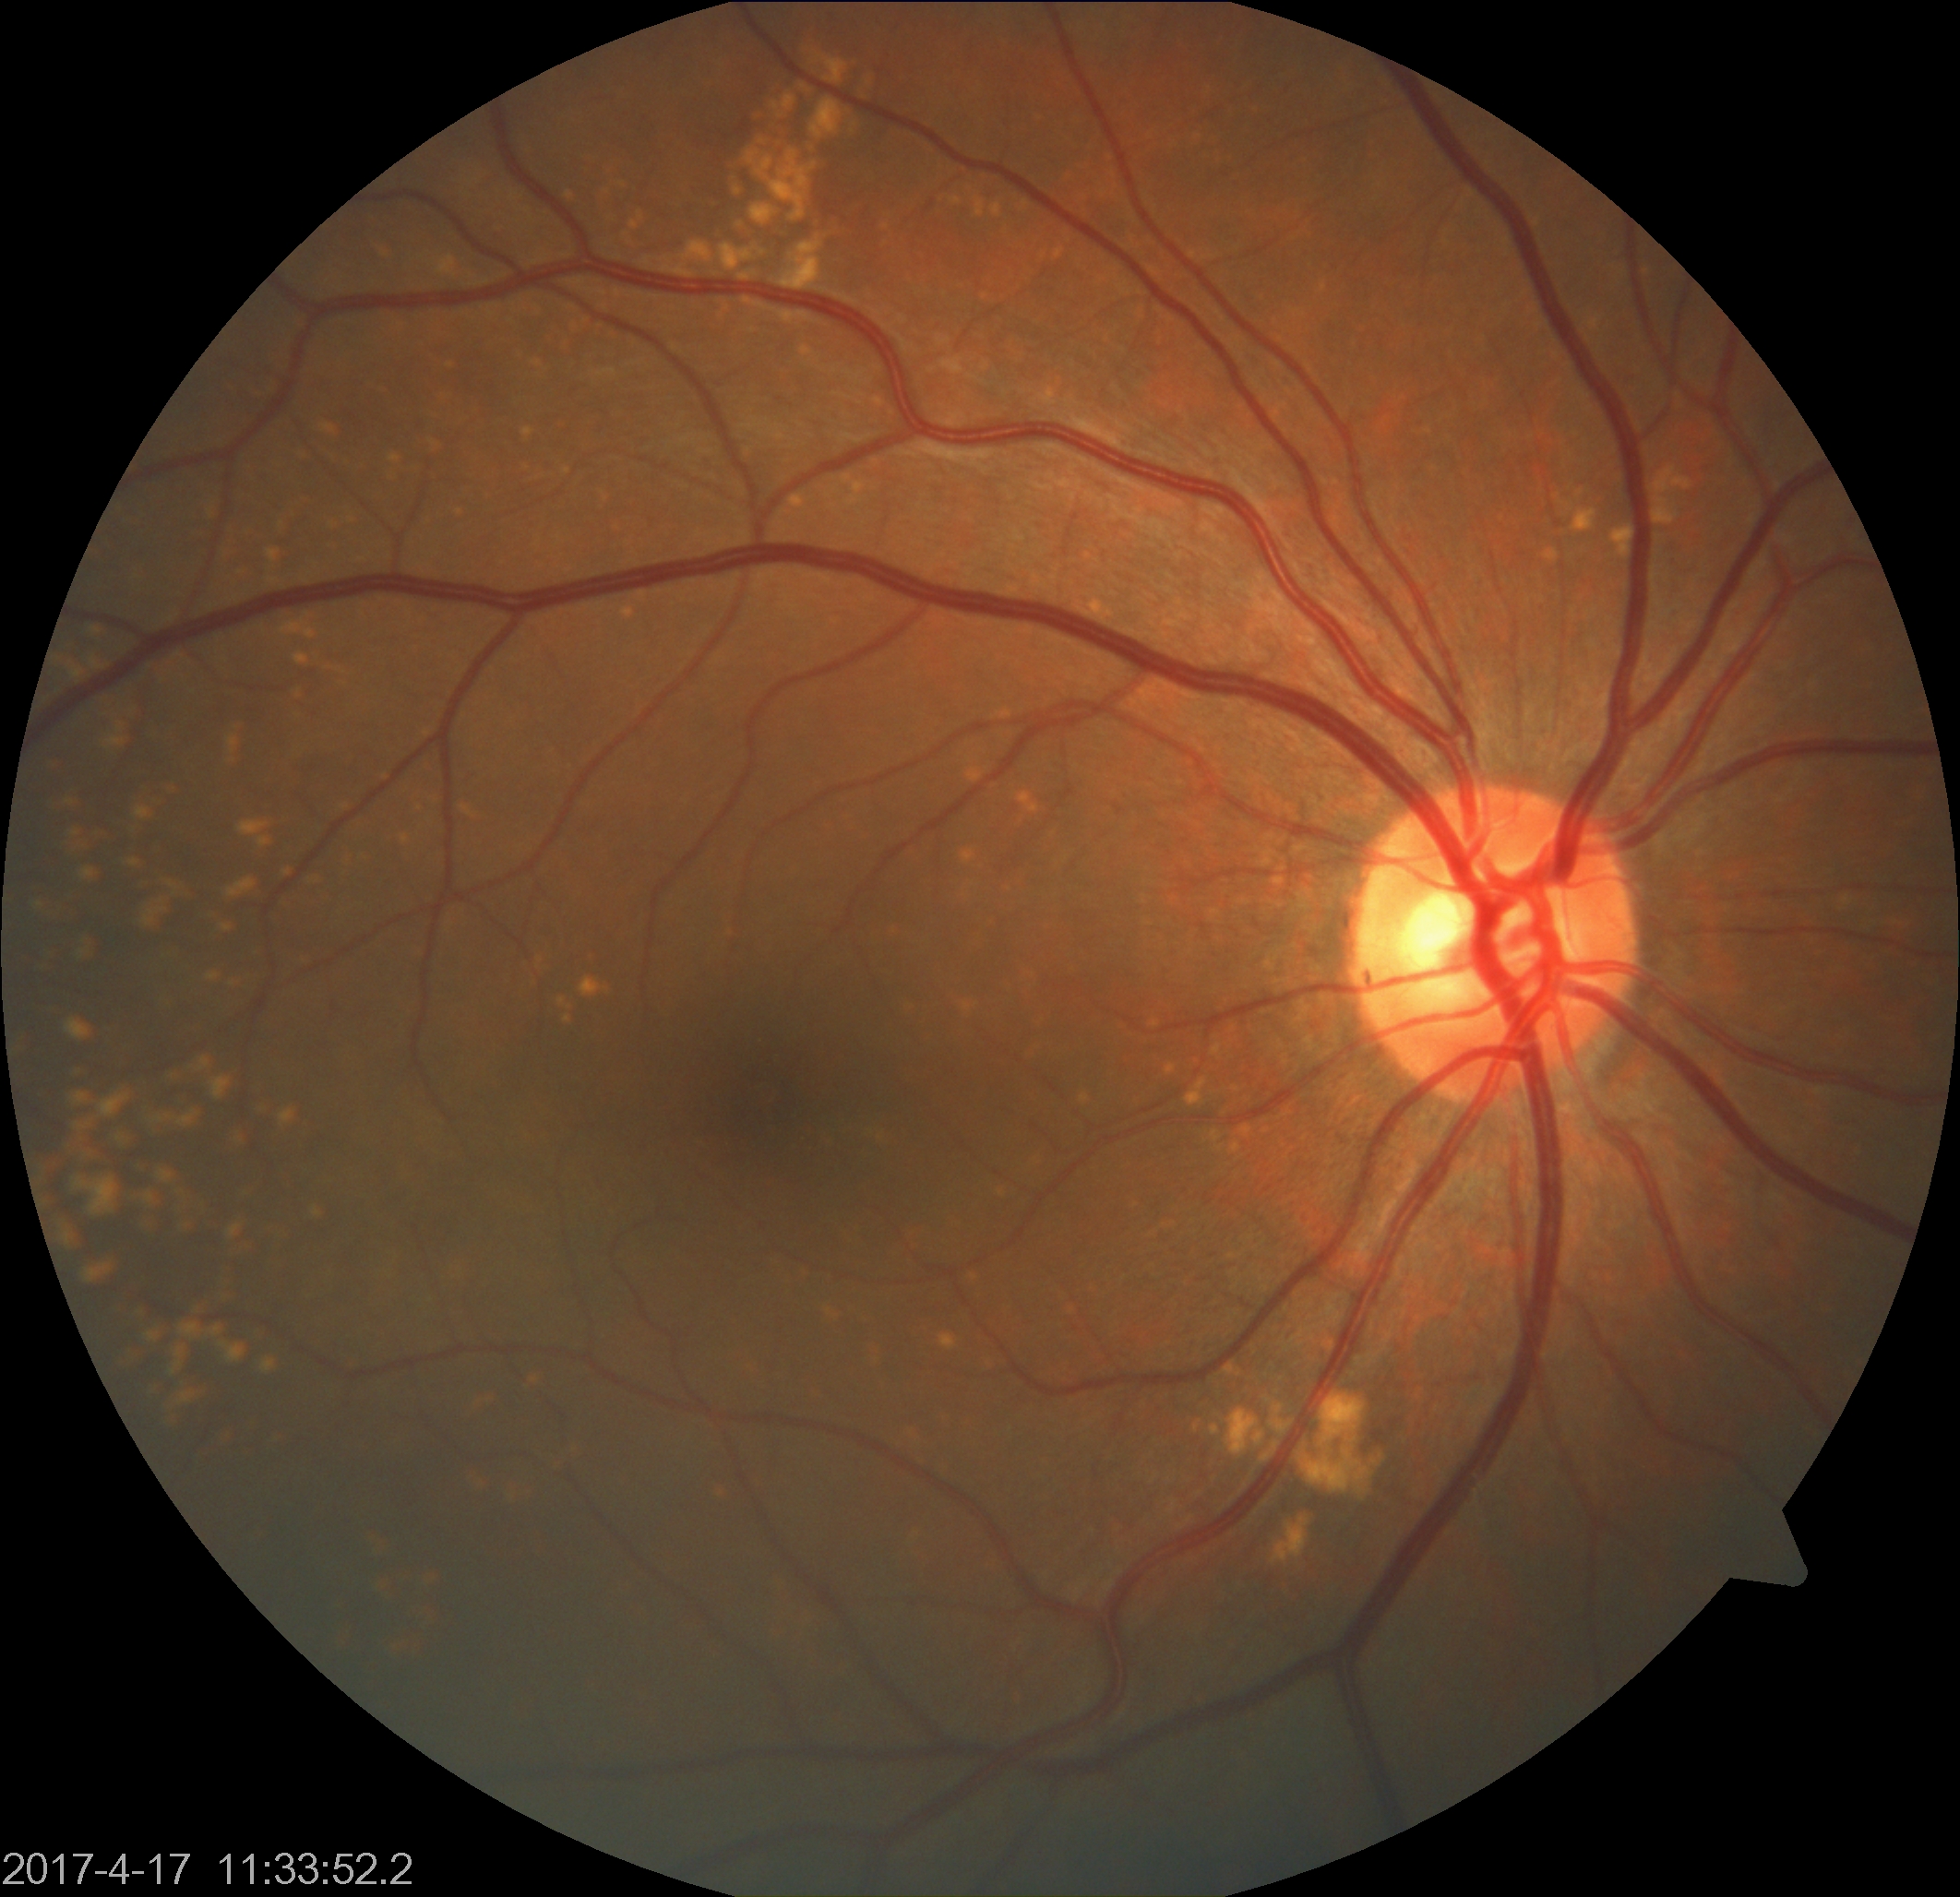

Appearance consistent with yellow-white spots or flecks.